45° field of view:
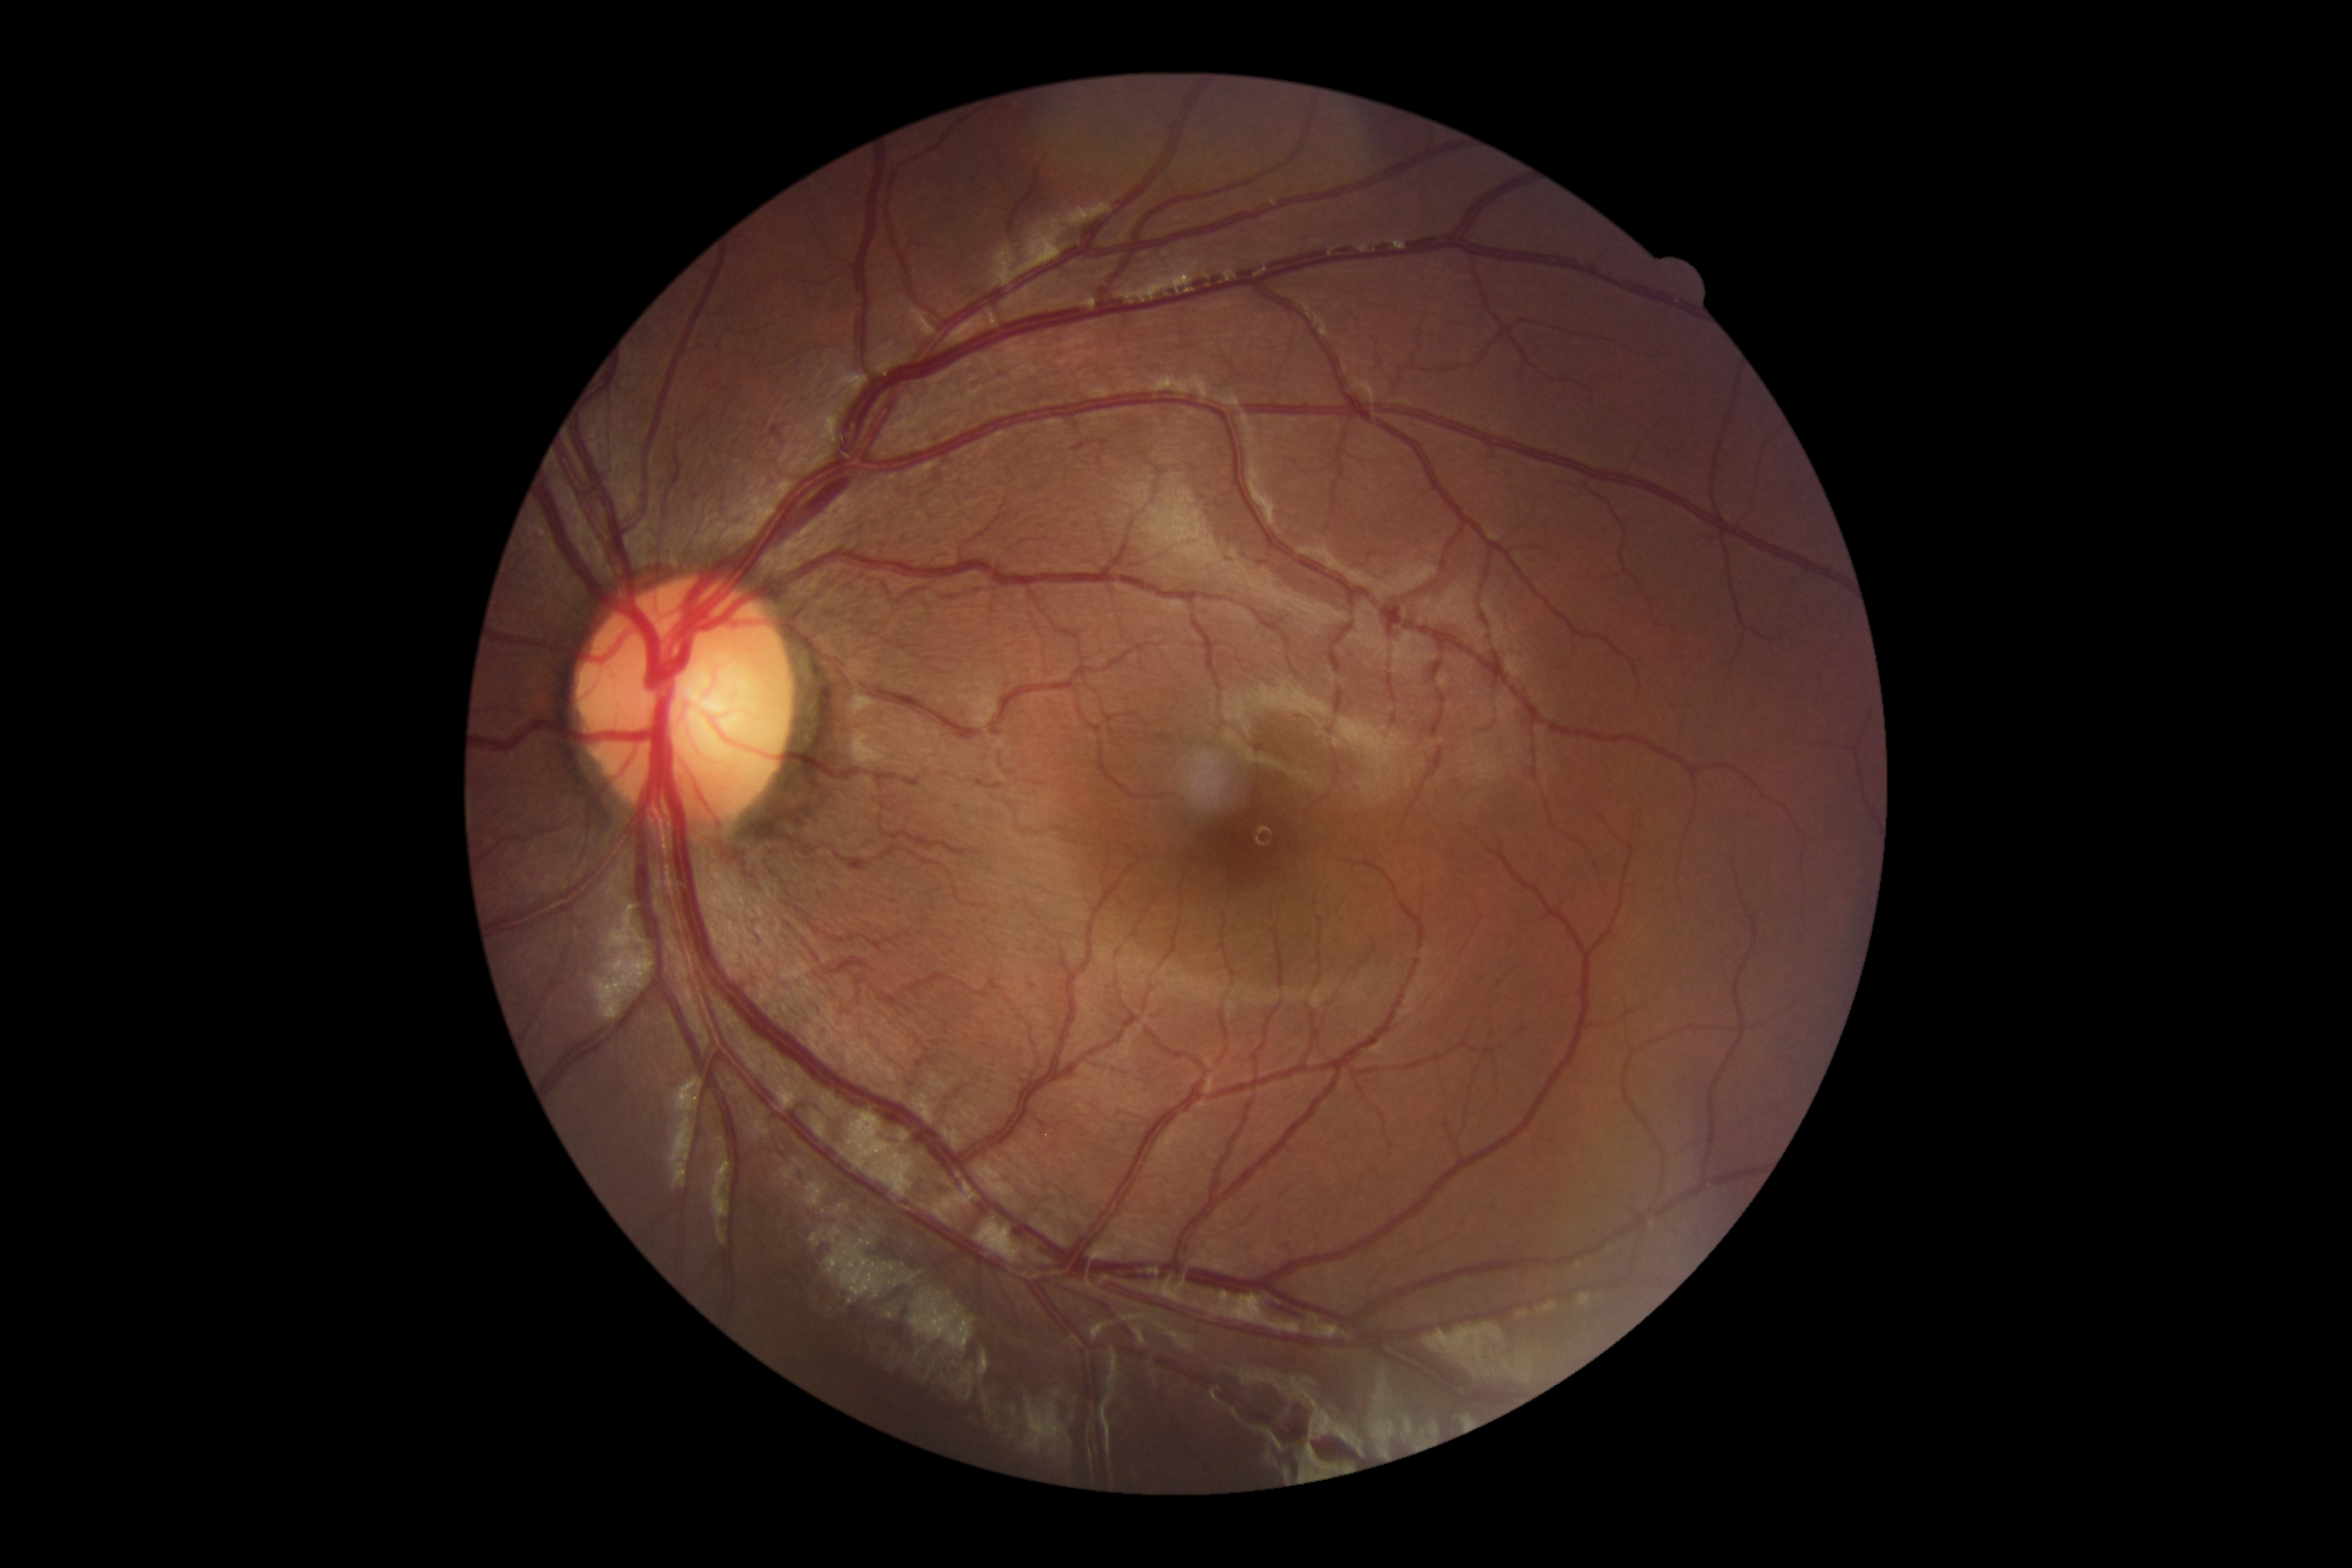 {
  "dr_grade": "grade 0 — no visible signs of diabetic retinopathy"
}